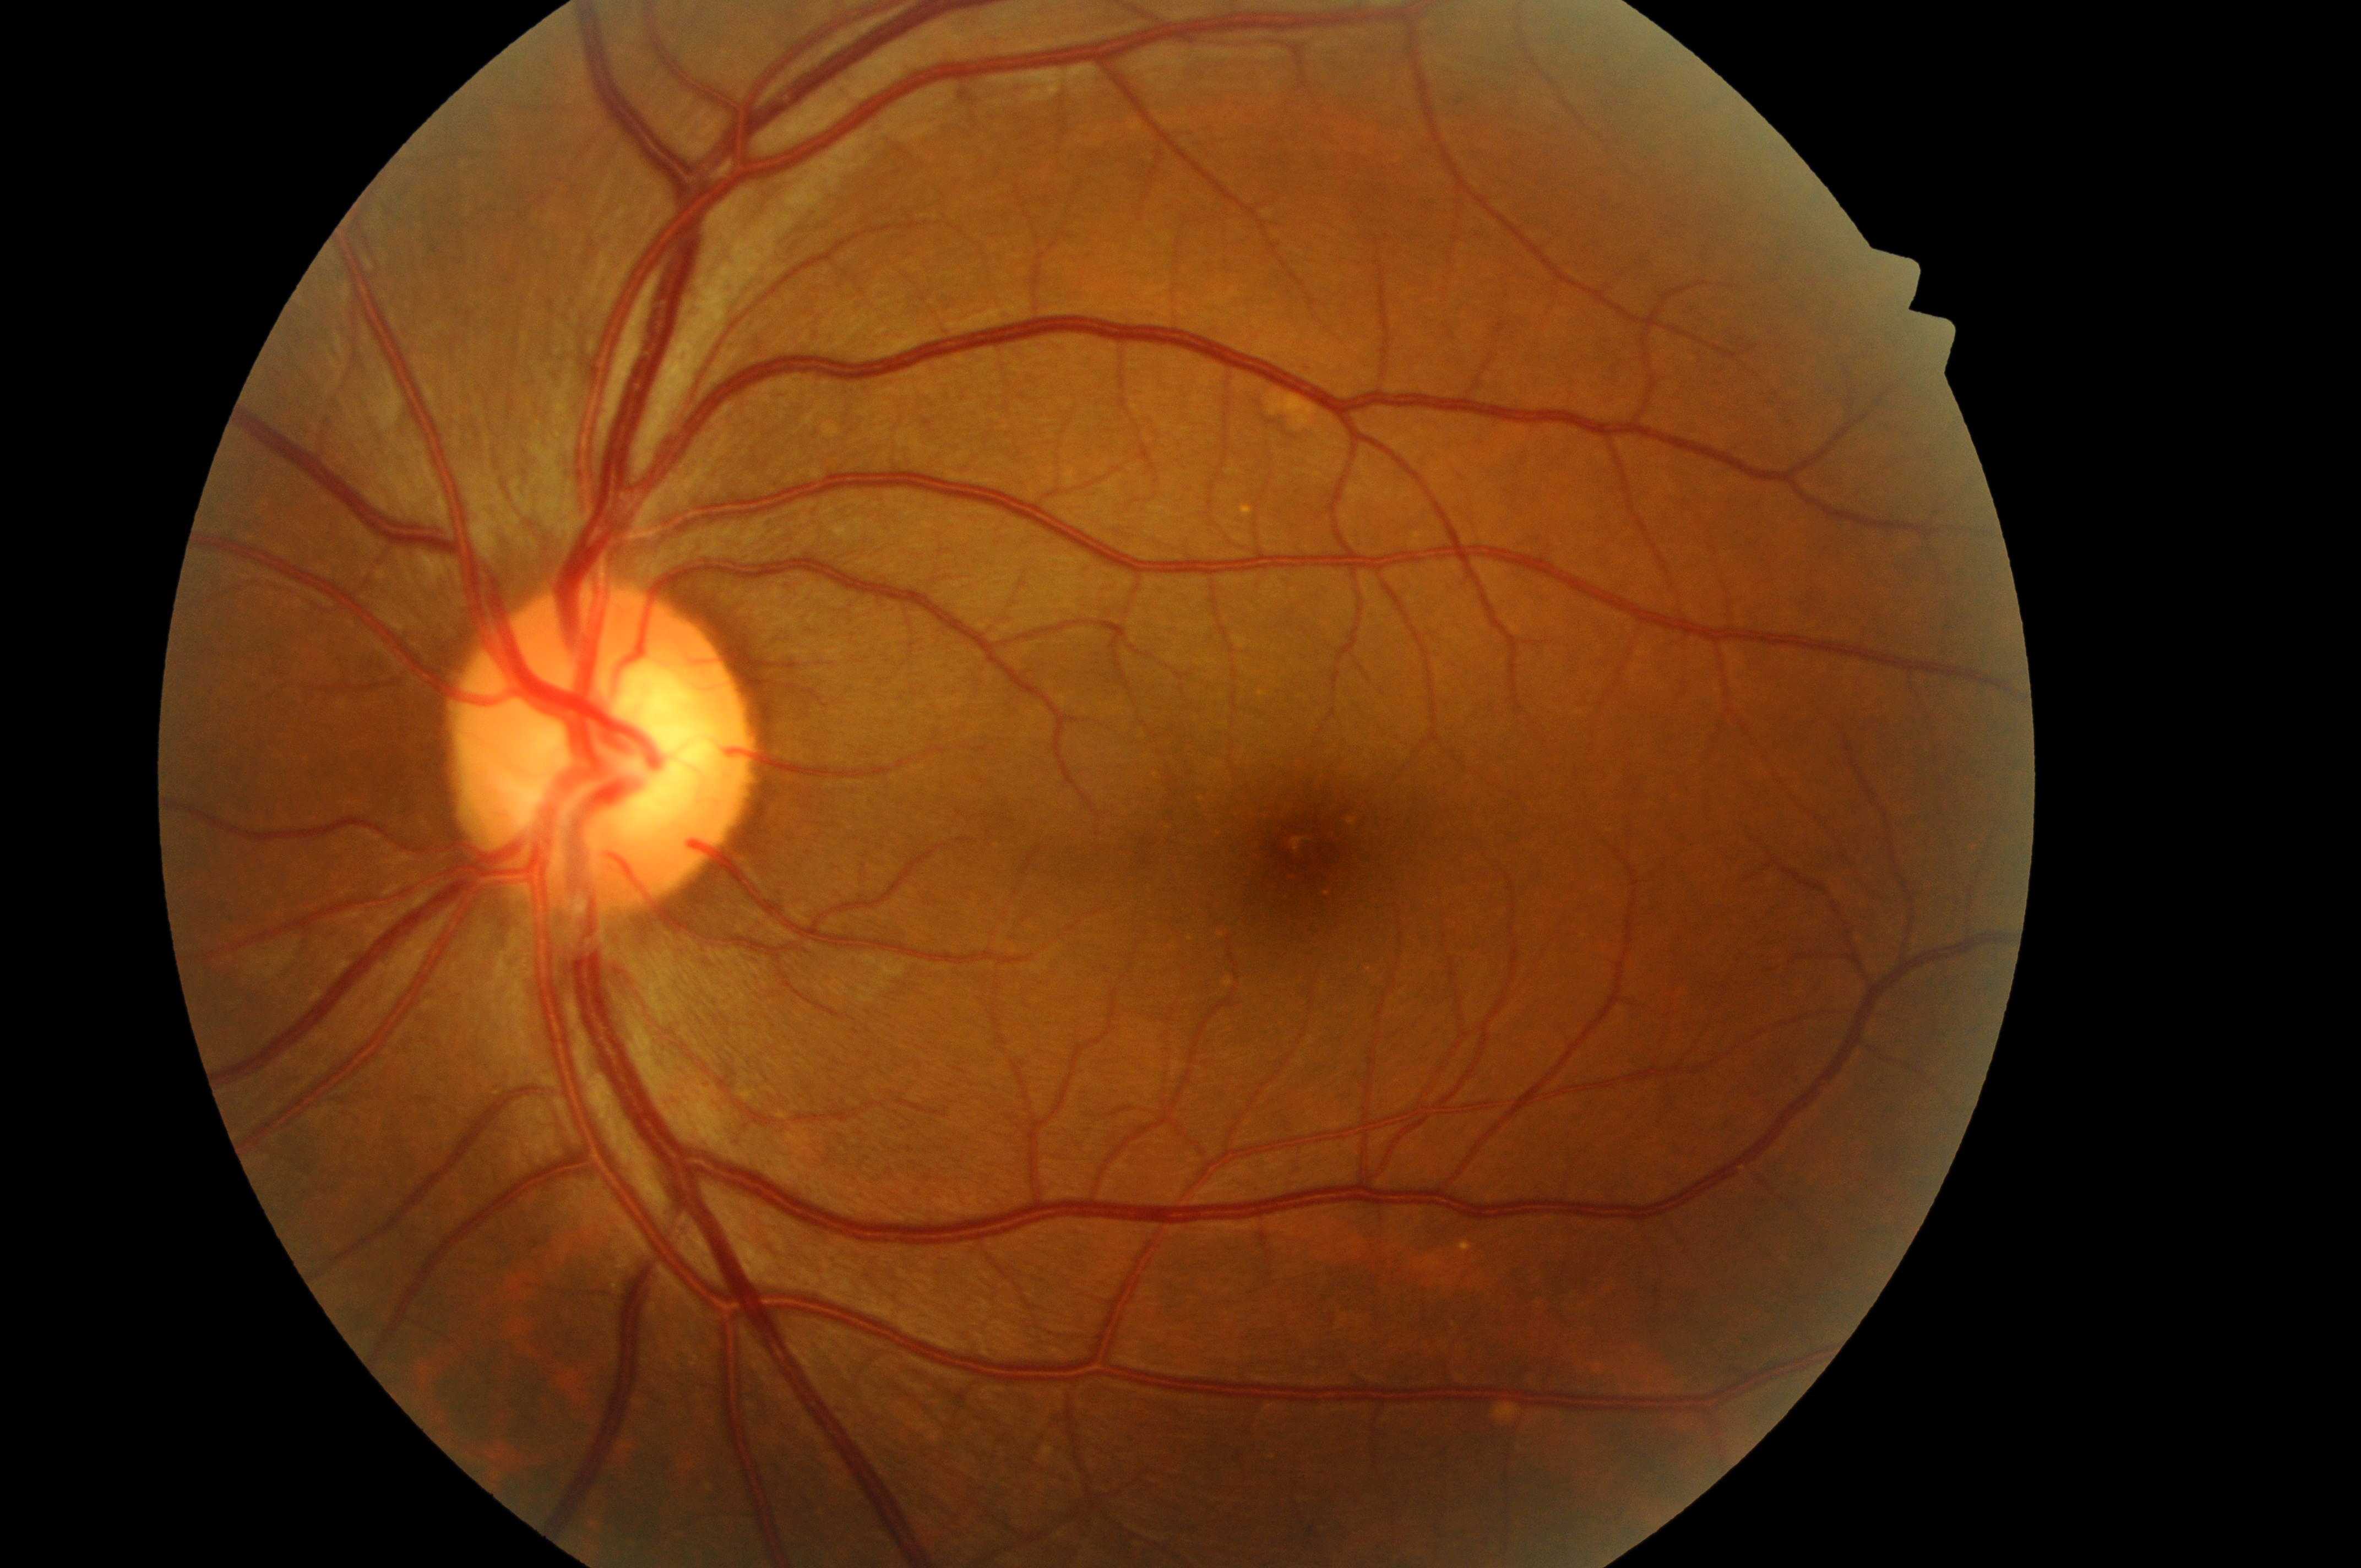 Optic disc center: 596, 759. Fovea located at 1322, 858. DME grade is 0 (no risk). DR is no apparent retinopathy (grade 0). Imaged eye: OS.